1659 x 2212 pixels, retinal fundus photograph, Remidio Fundus on Phone (FOP) camera:
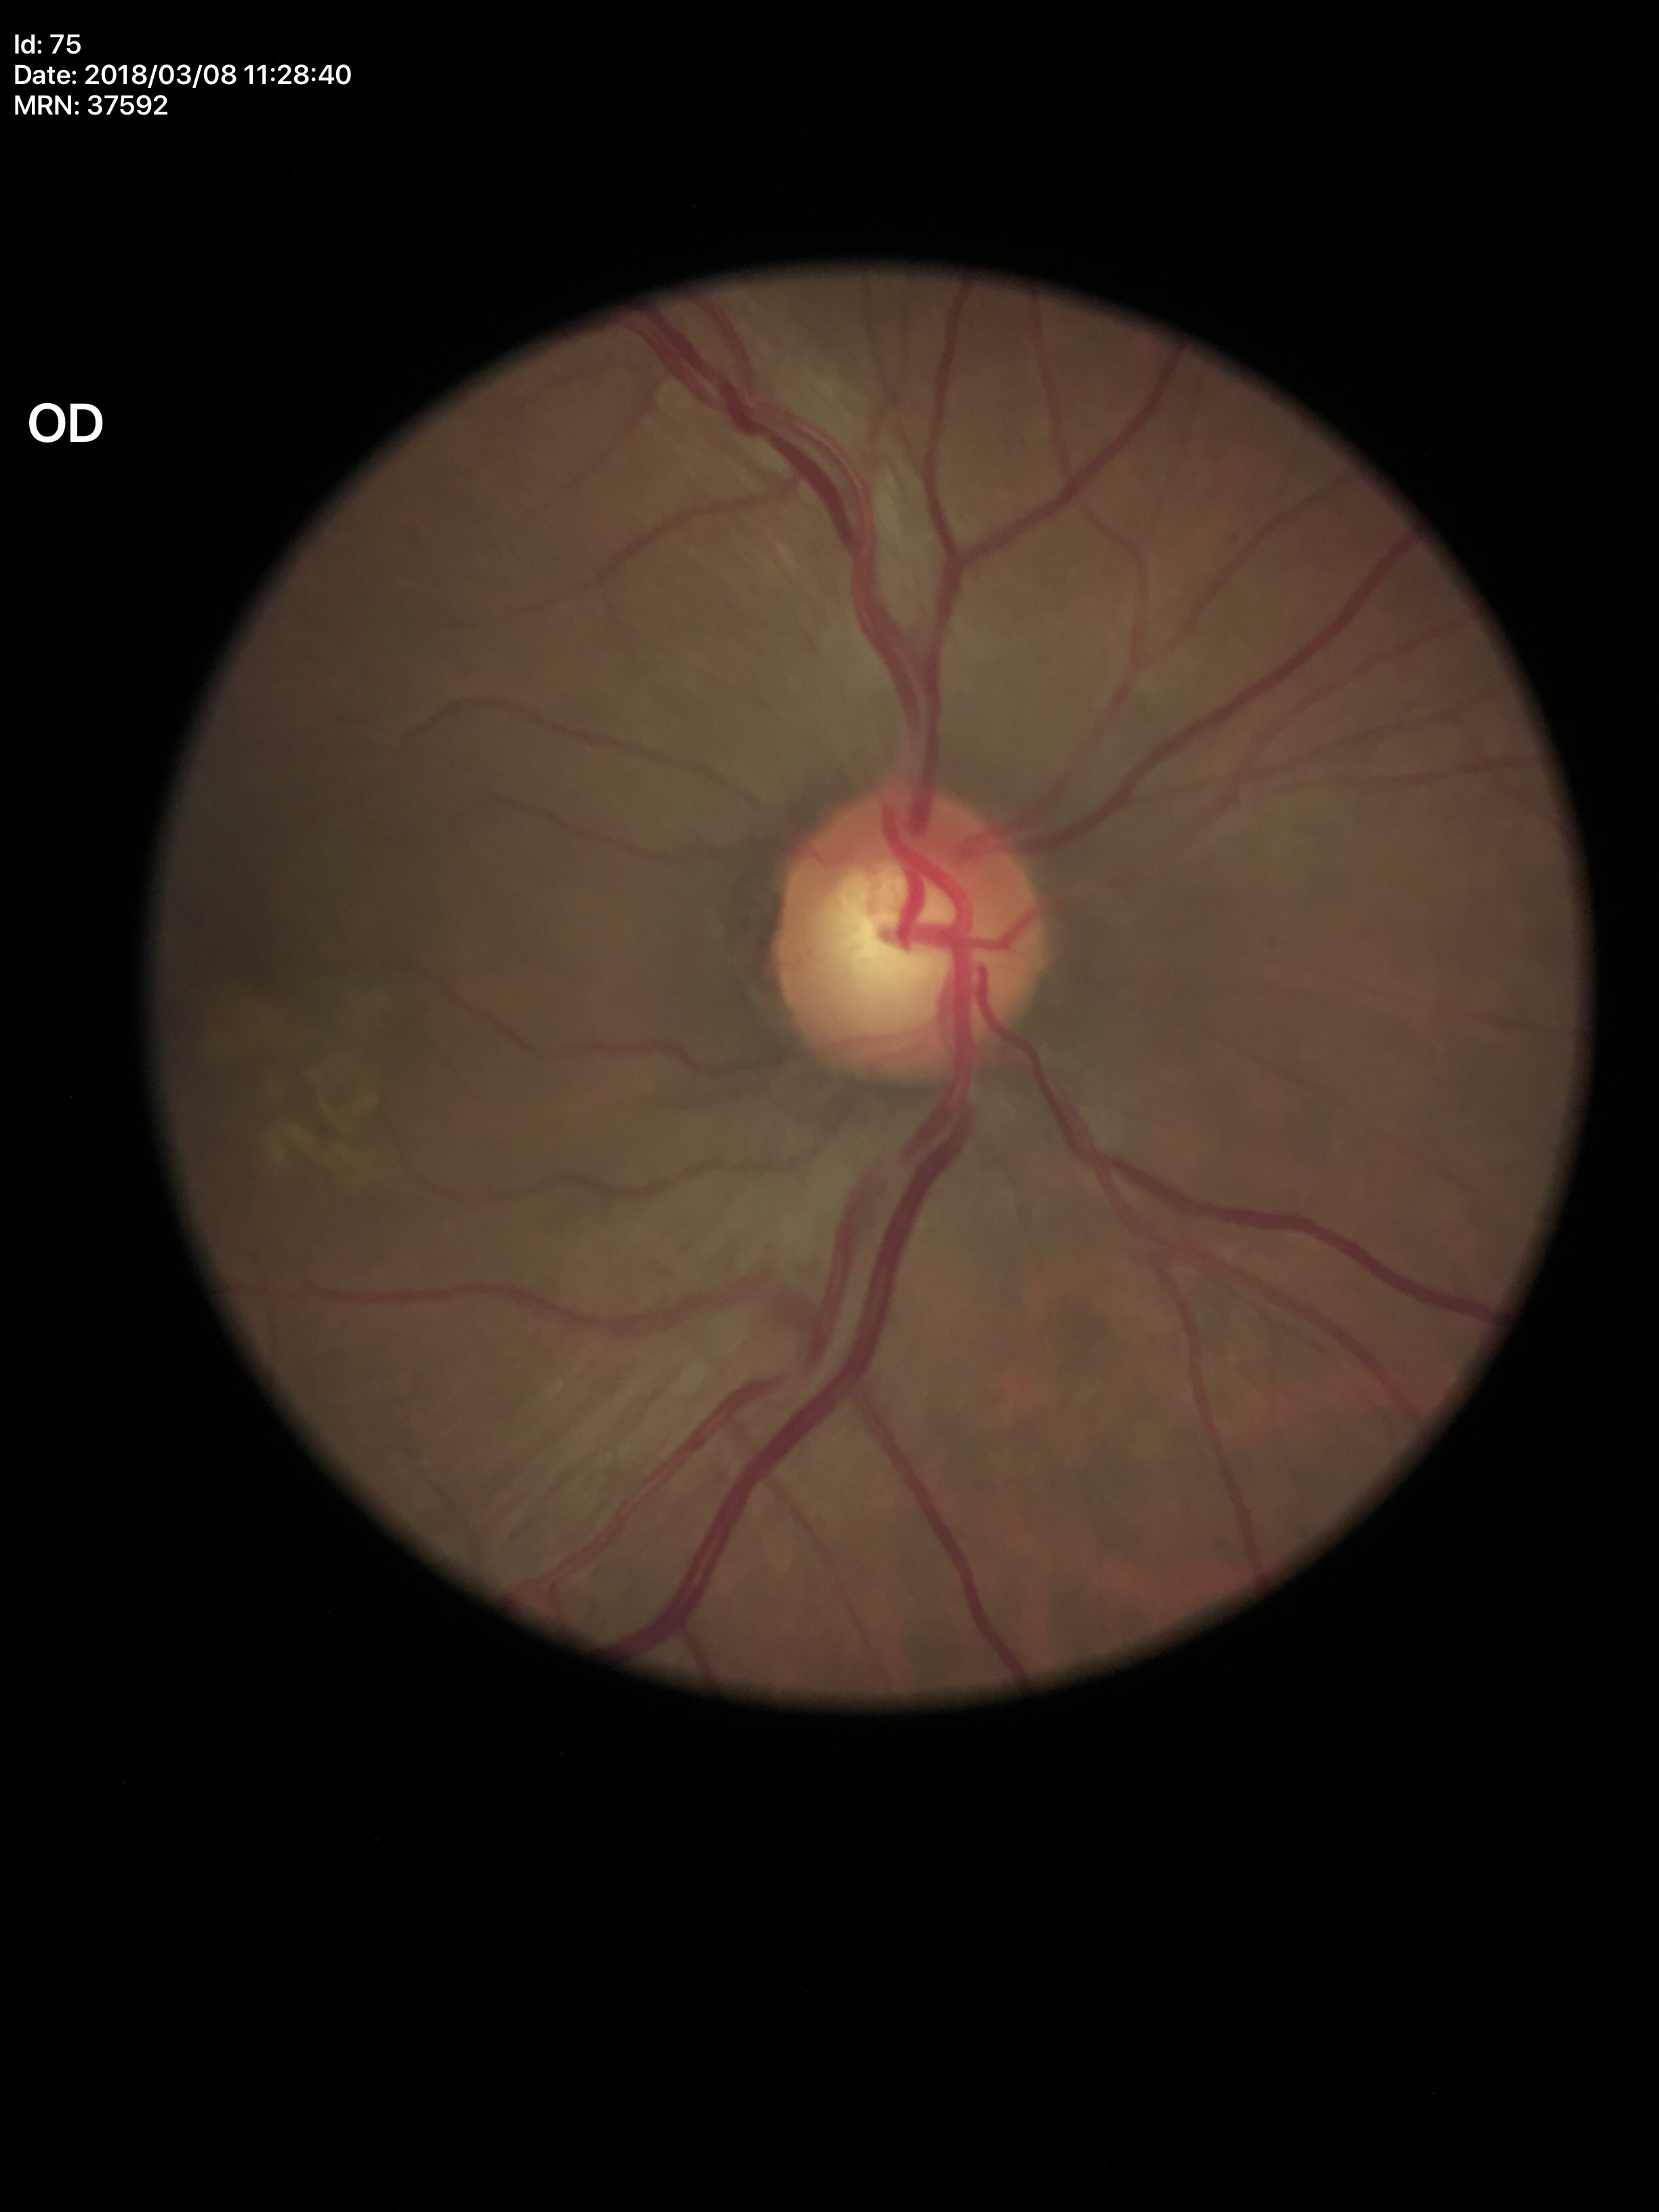
Suspicious for glaucoma. Vertical cup-to-disc ratio of 0.66. Horizontal cup-disc ratio: 0.62.